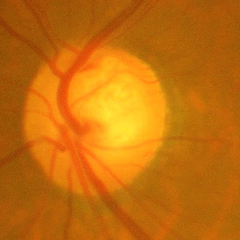
Impression: advanced glaucoma.